848 by 848 pixels; CFP; FOV: 45 degrees; without pupil dilation: 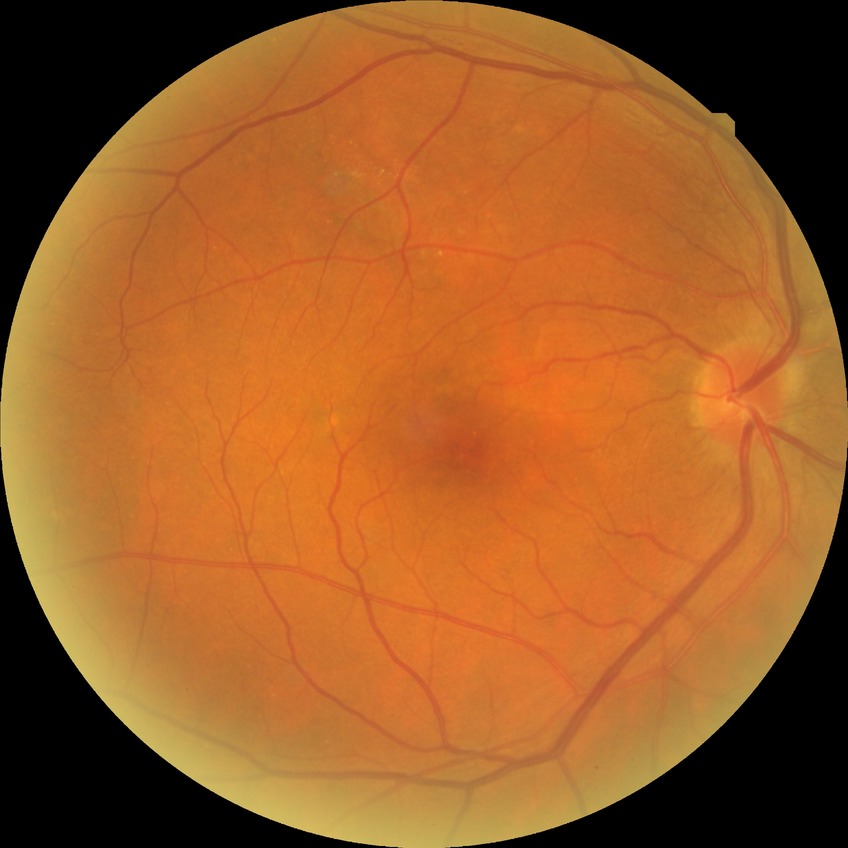 Diabetic retinopathy (DR) is NDR (no diabetic retinopathy).